Acquired with a Remidio smartphone fundus camera — 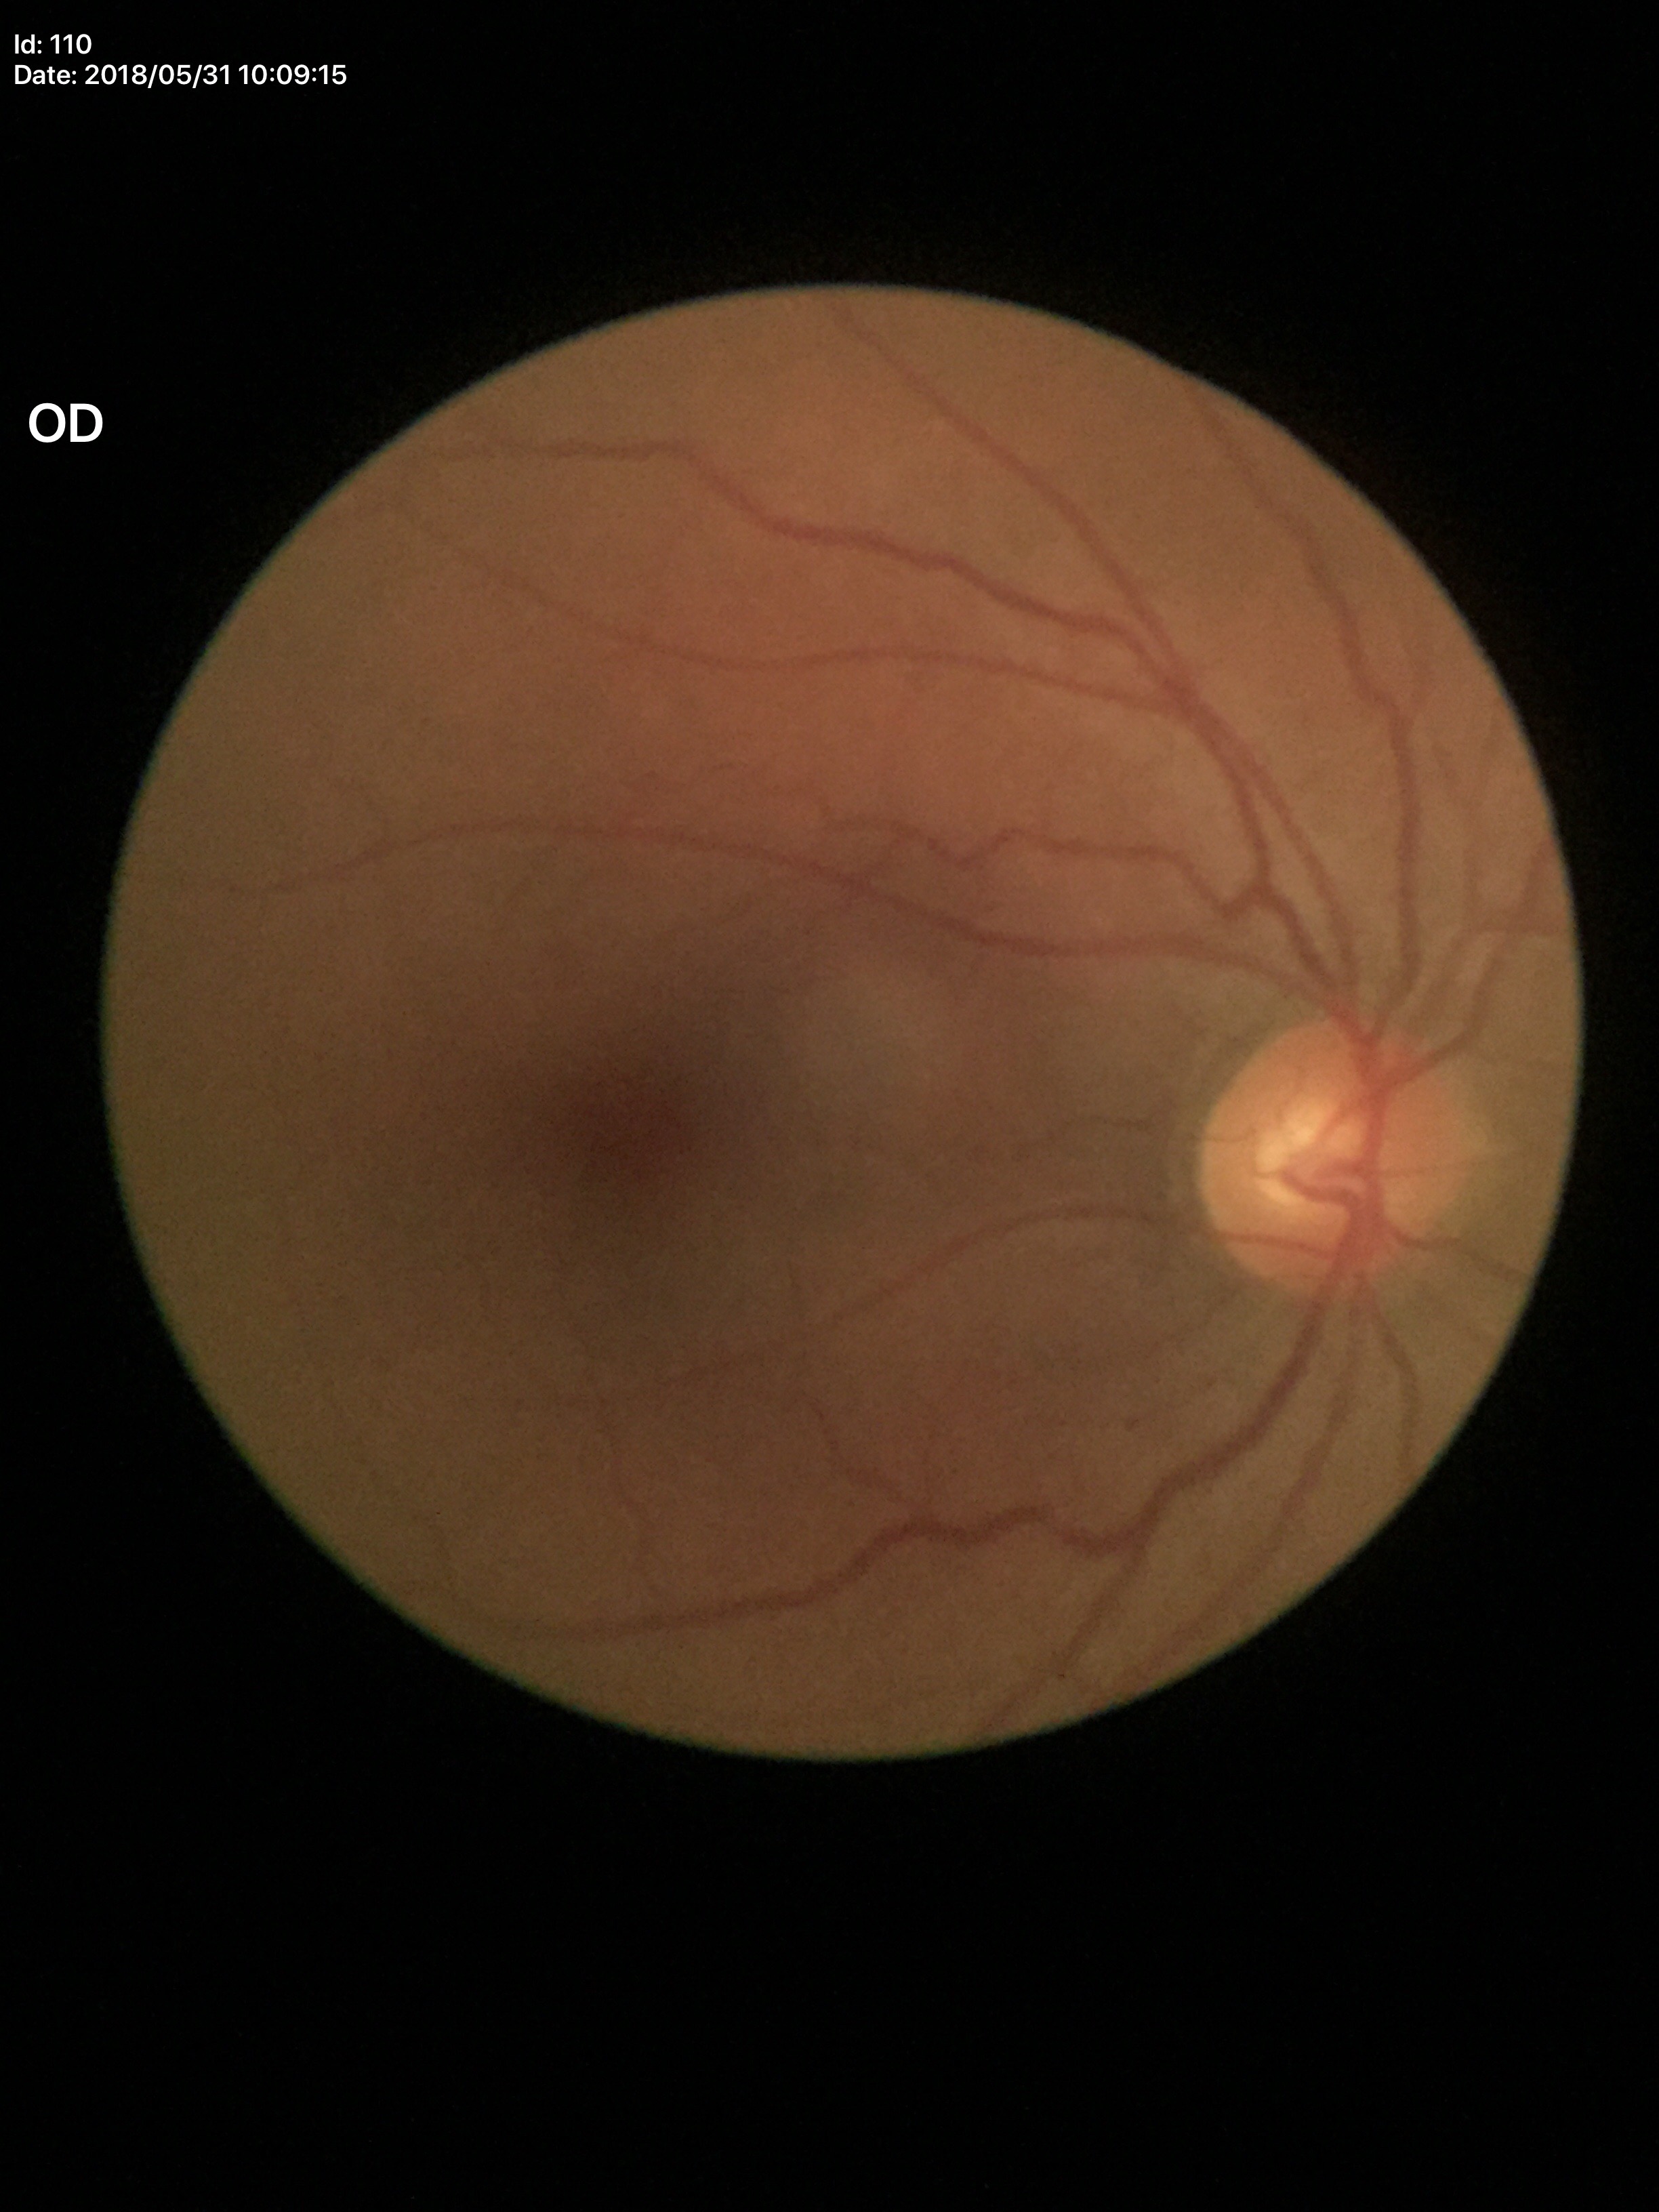
Glaucoma evaluation: no suspicious findings. Horizontal cup-disc ratio: 0.54. Vertical C/D ratio of 0.54.